Non-mydriatic fundus camera · camera: Nidek AFC-330 — 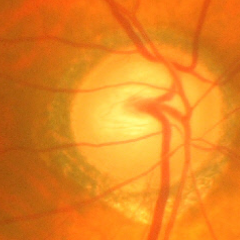 Severe glaucomatous damage.